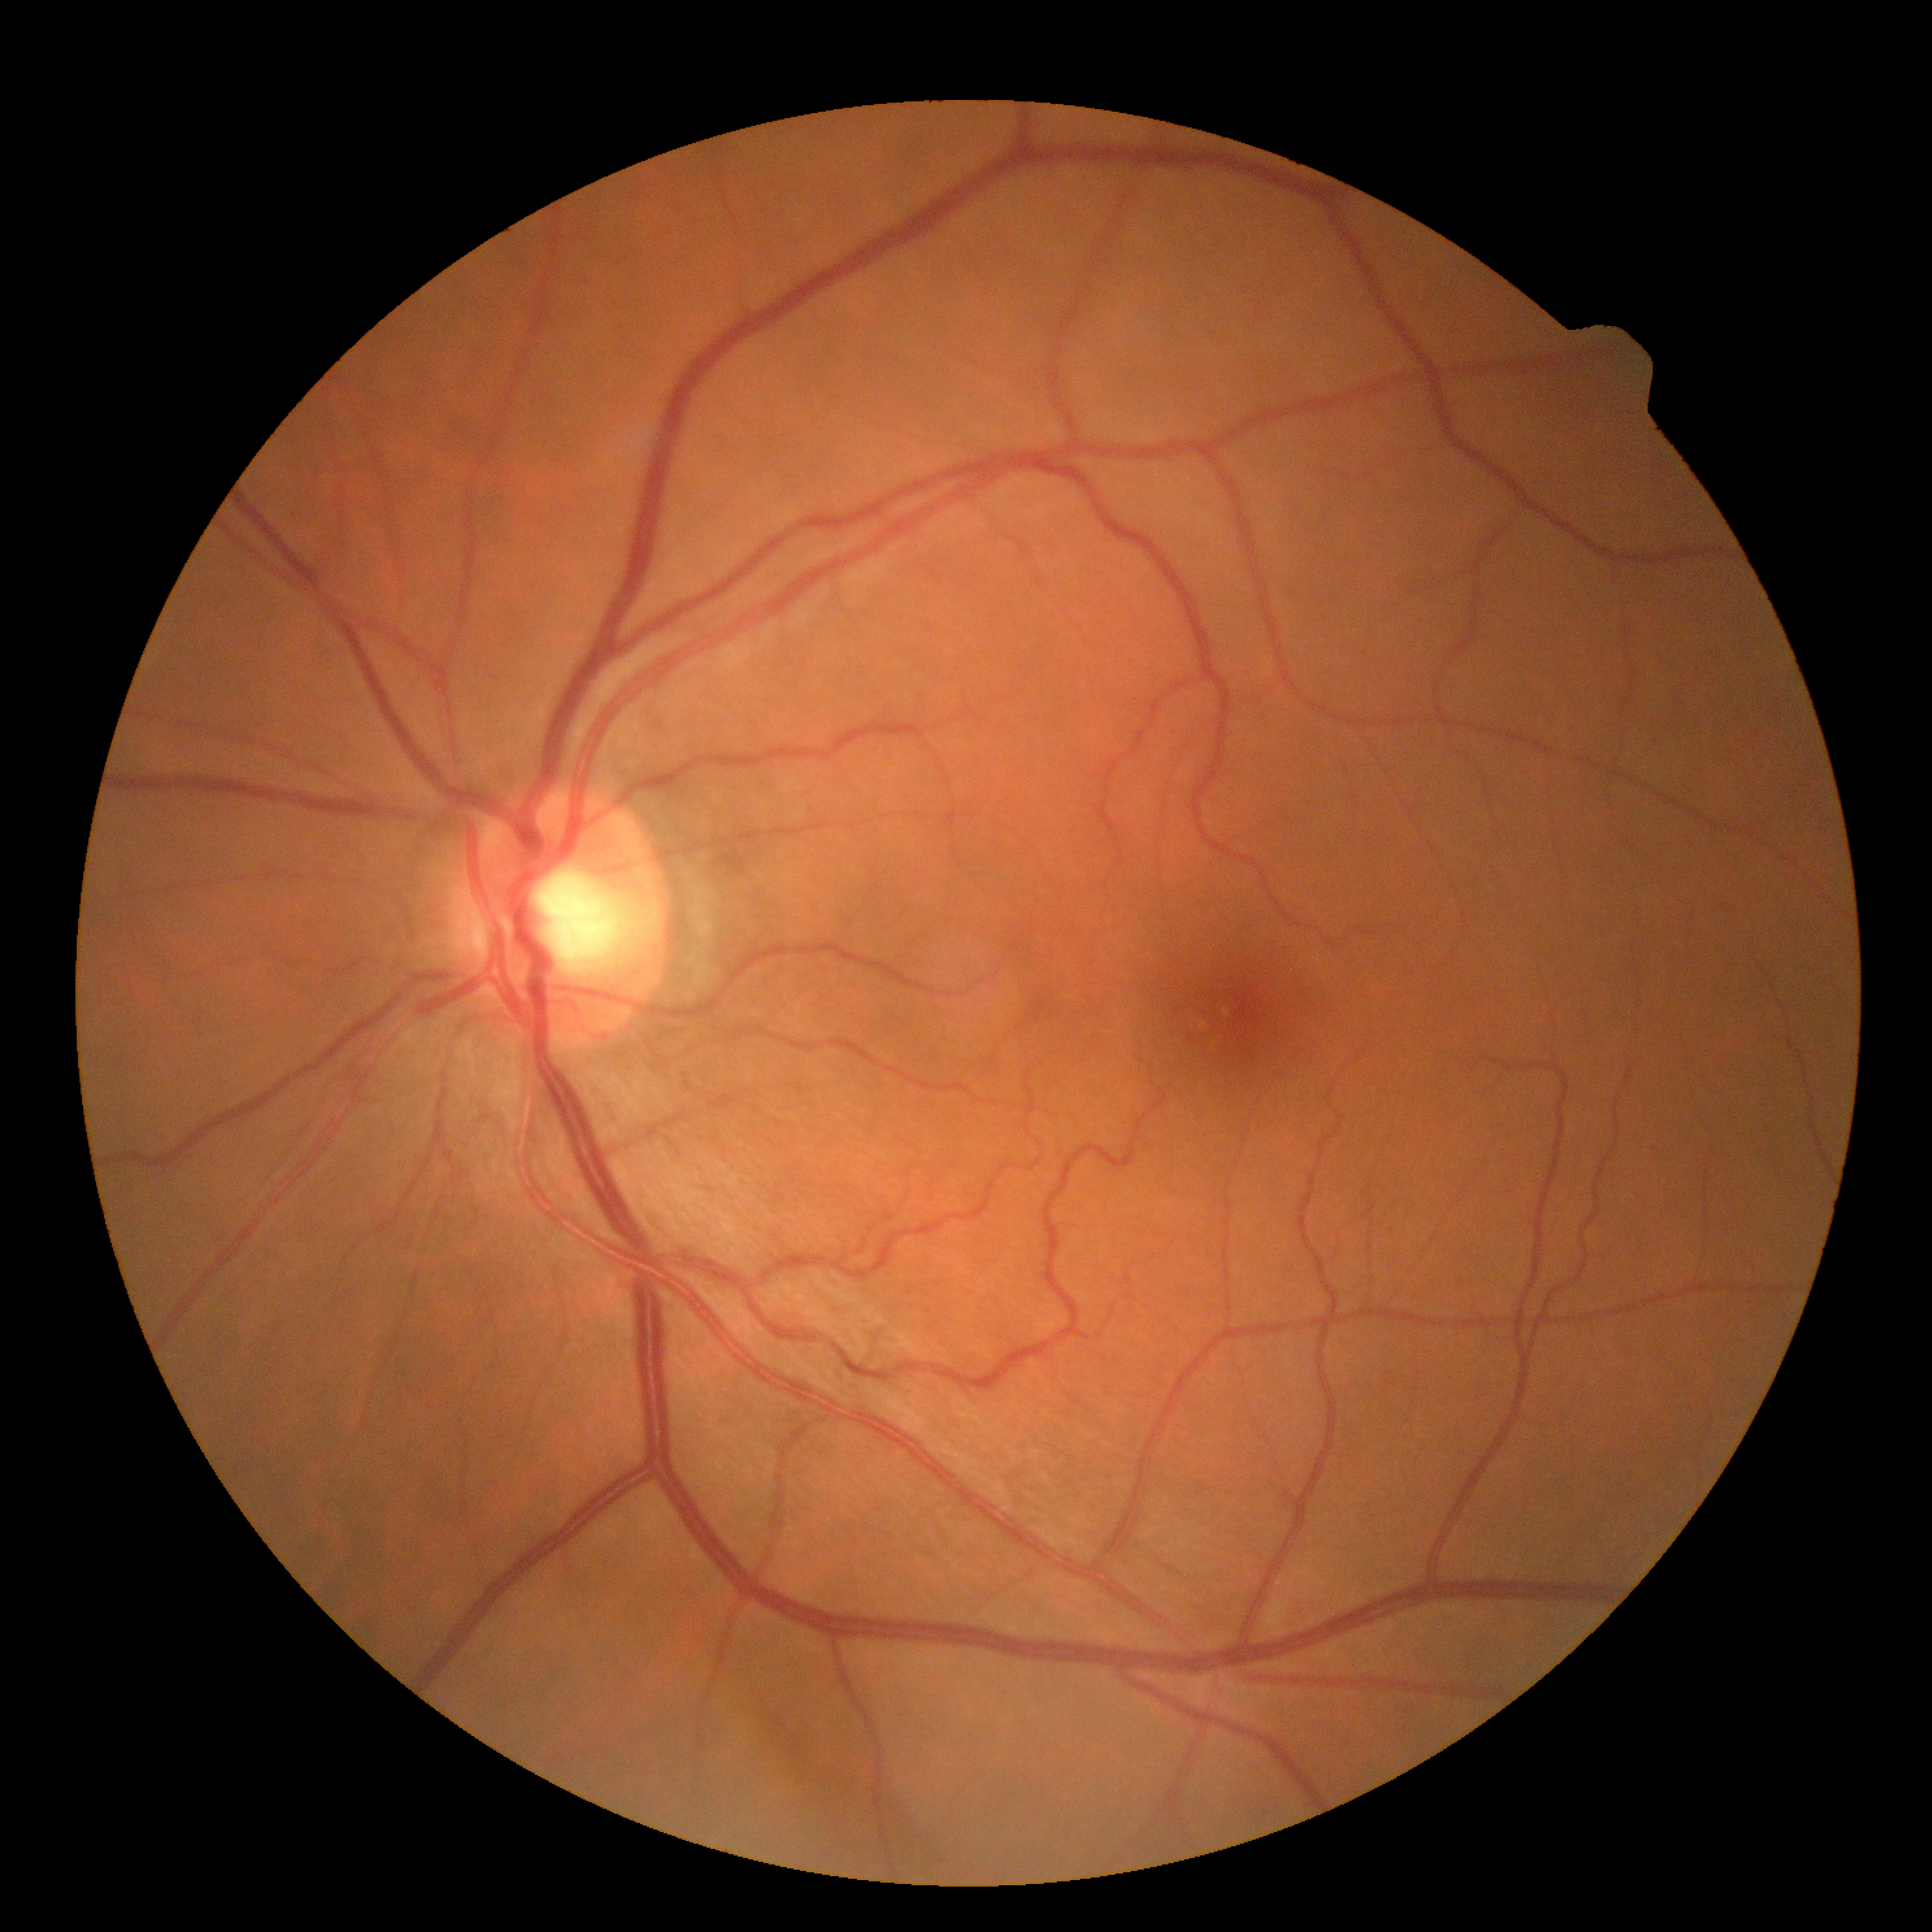
diabetic retinopathy (DR) = grade 0 (no apparent retinopathy).